1932 x 1932 pixels; FOV: 45 degrees; CFP: 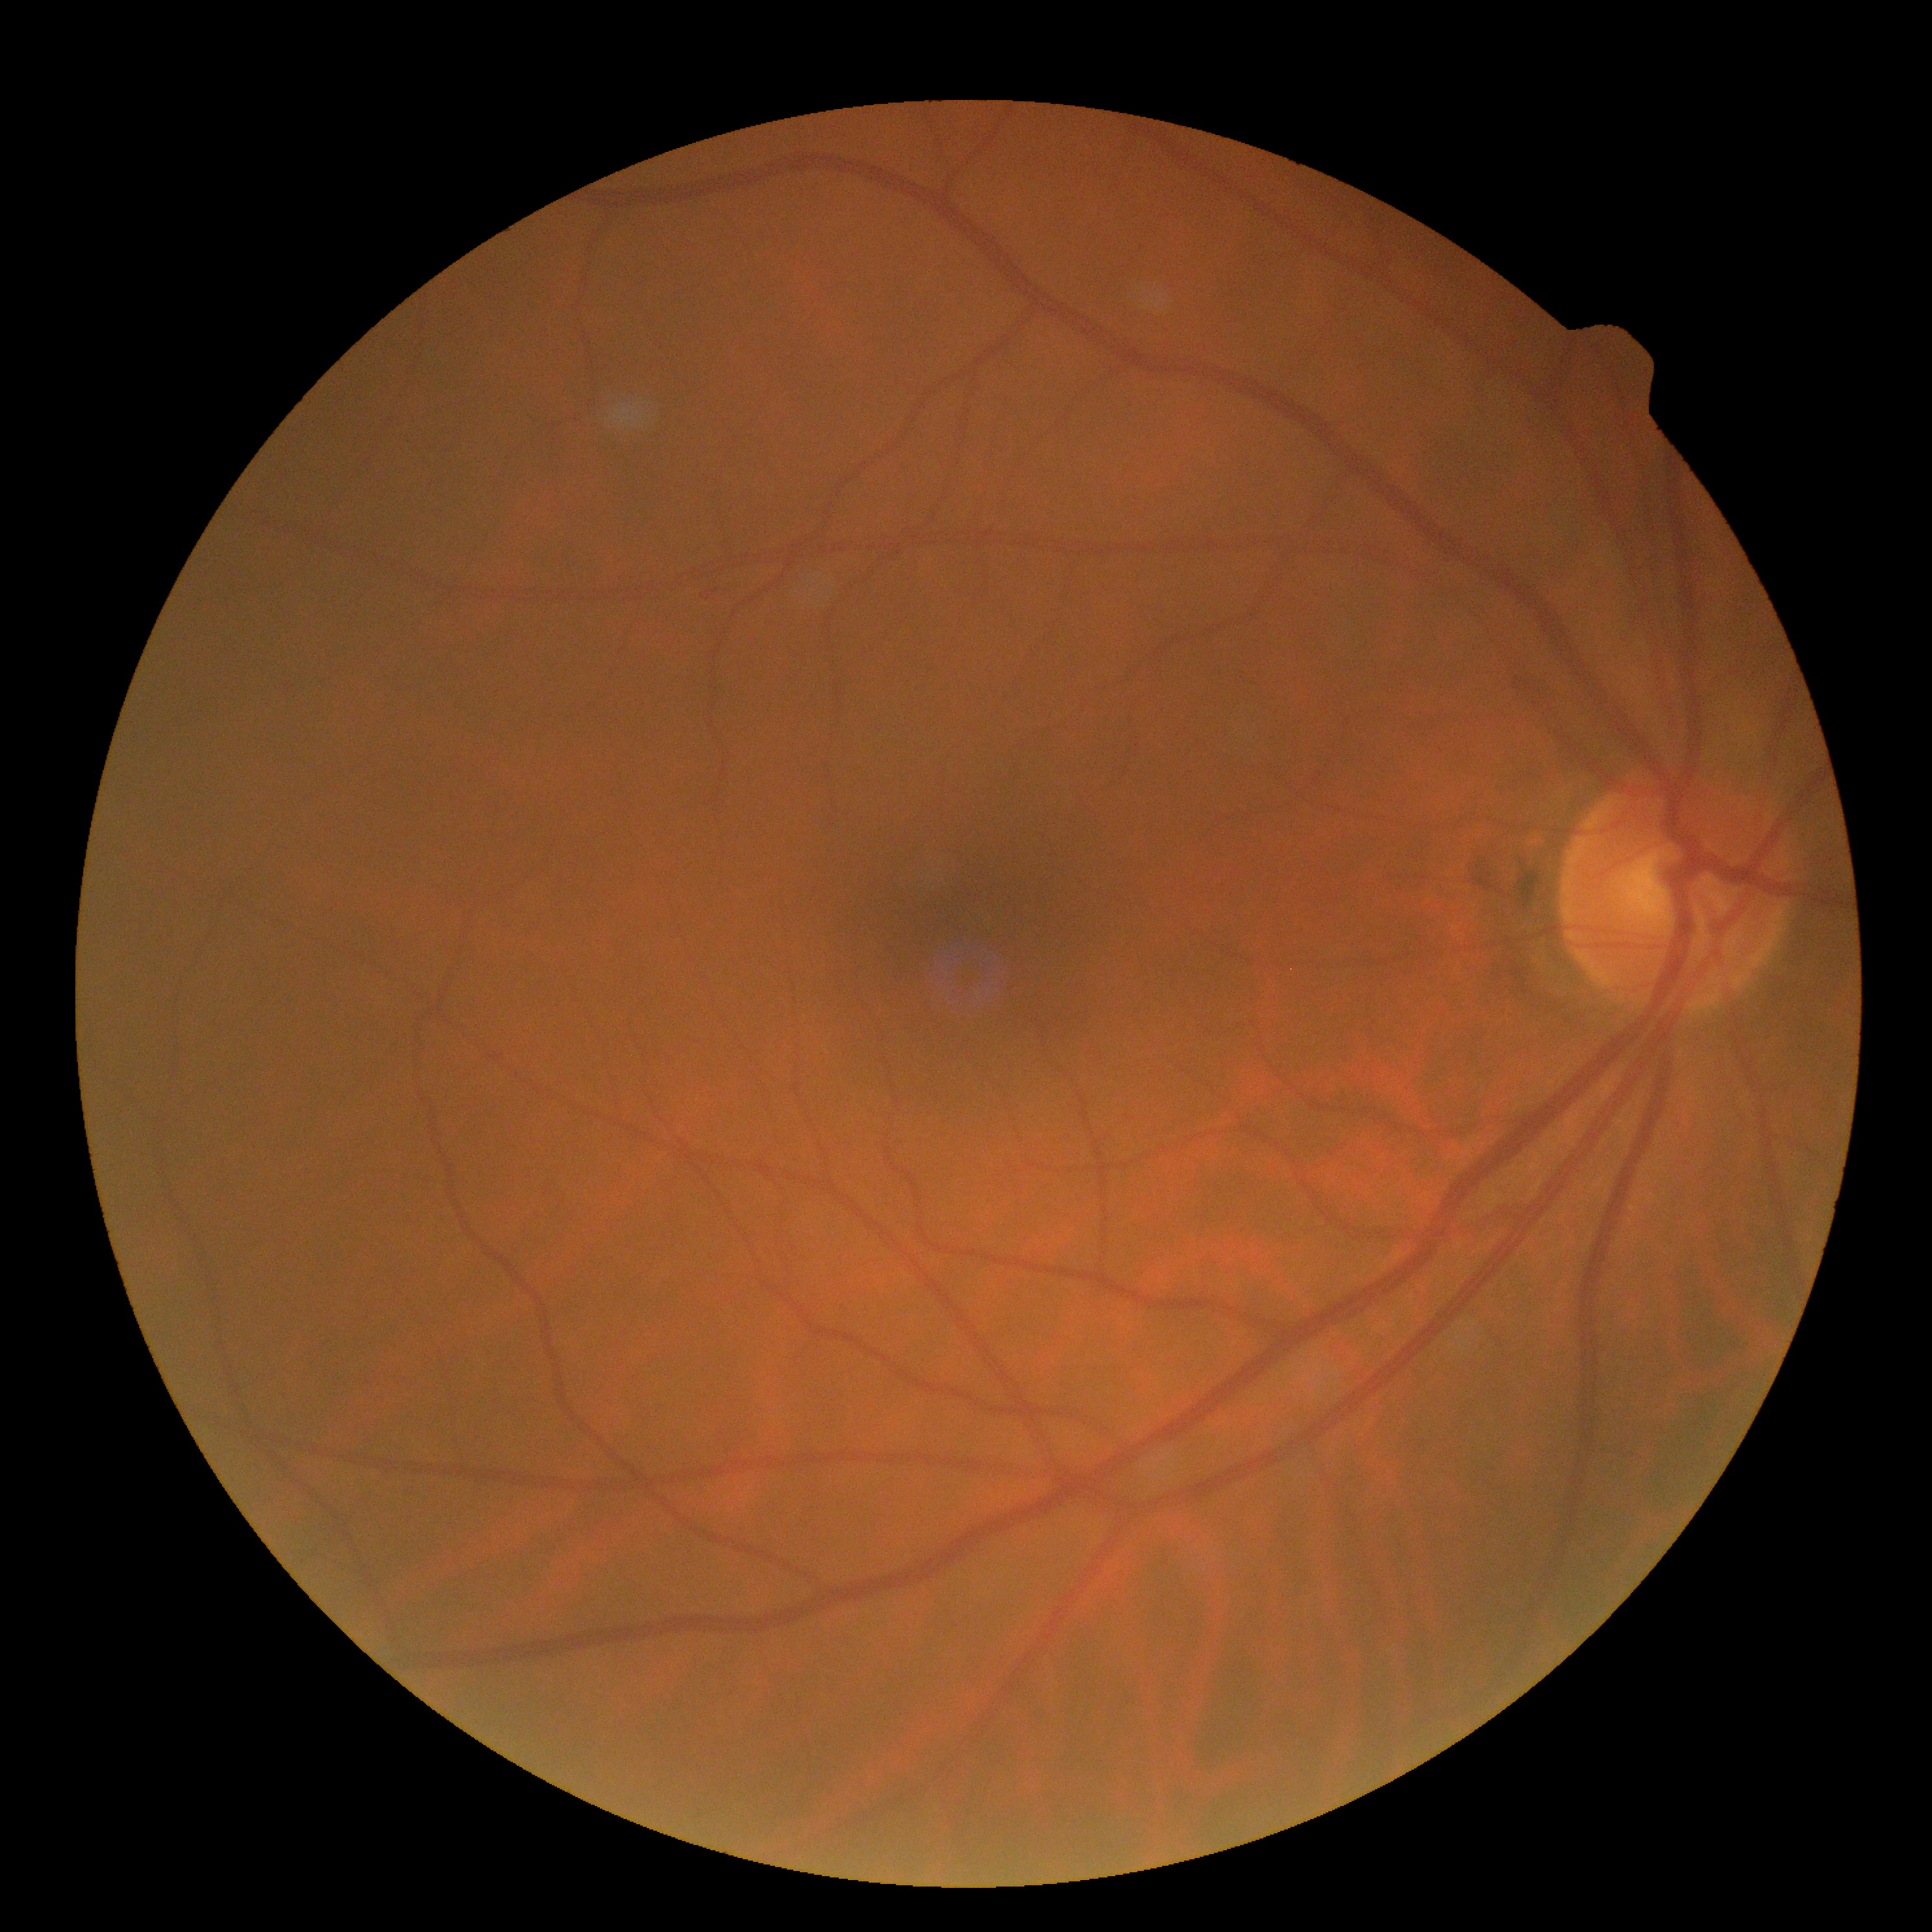 diabetic retinopathy severity = 0.